848x848, nonmydriatic fundus photograph, CFP, NIDEK AFC-230, 45° FOV:
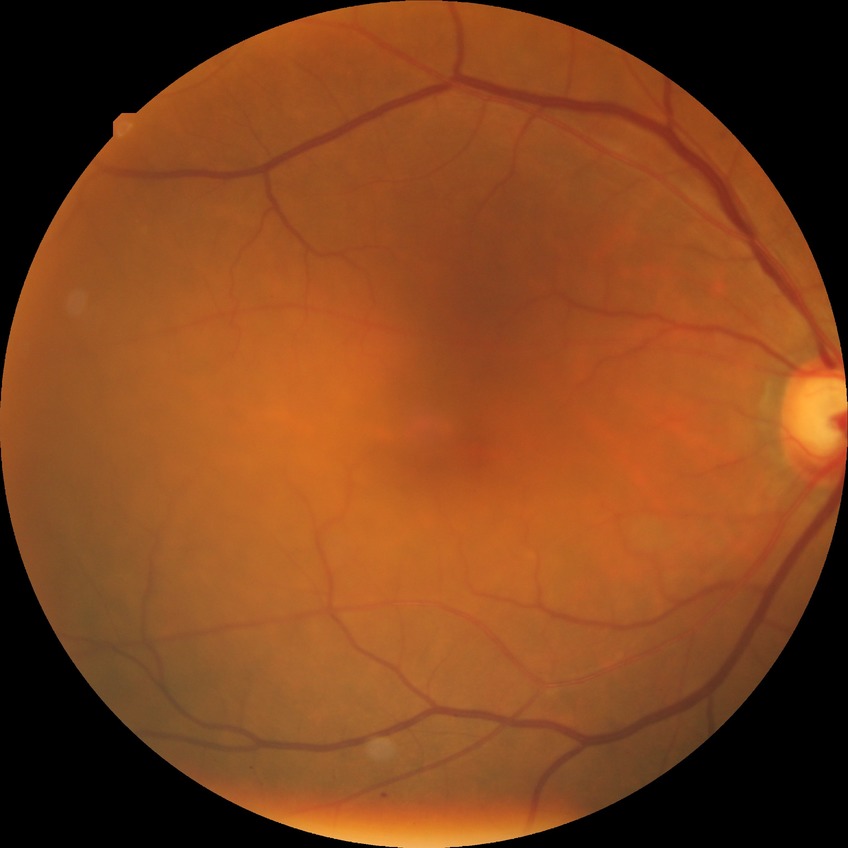

Modified Davis grade: SDR.